Nonmydriatic fundus photograph — 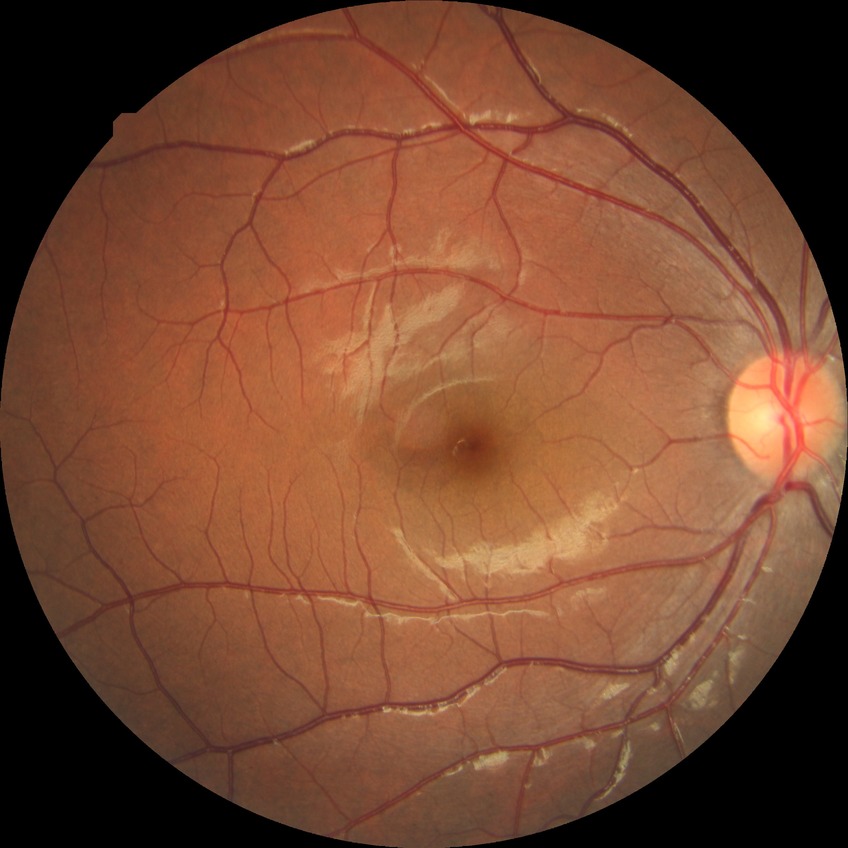
{"davis_grade": "NDR (no diabetic retinopathy)"}